Color fundus image: 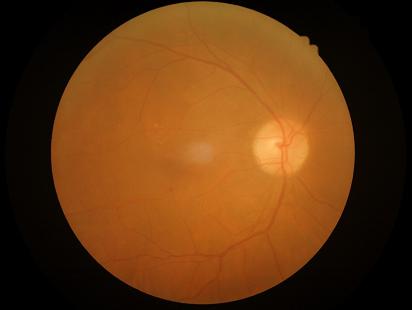 The image is blurry.
Overall image quality is poor.
Narrow intensity range; structures are hard to distinguish.